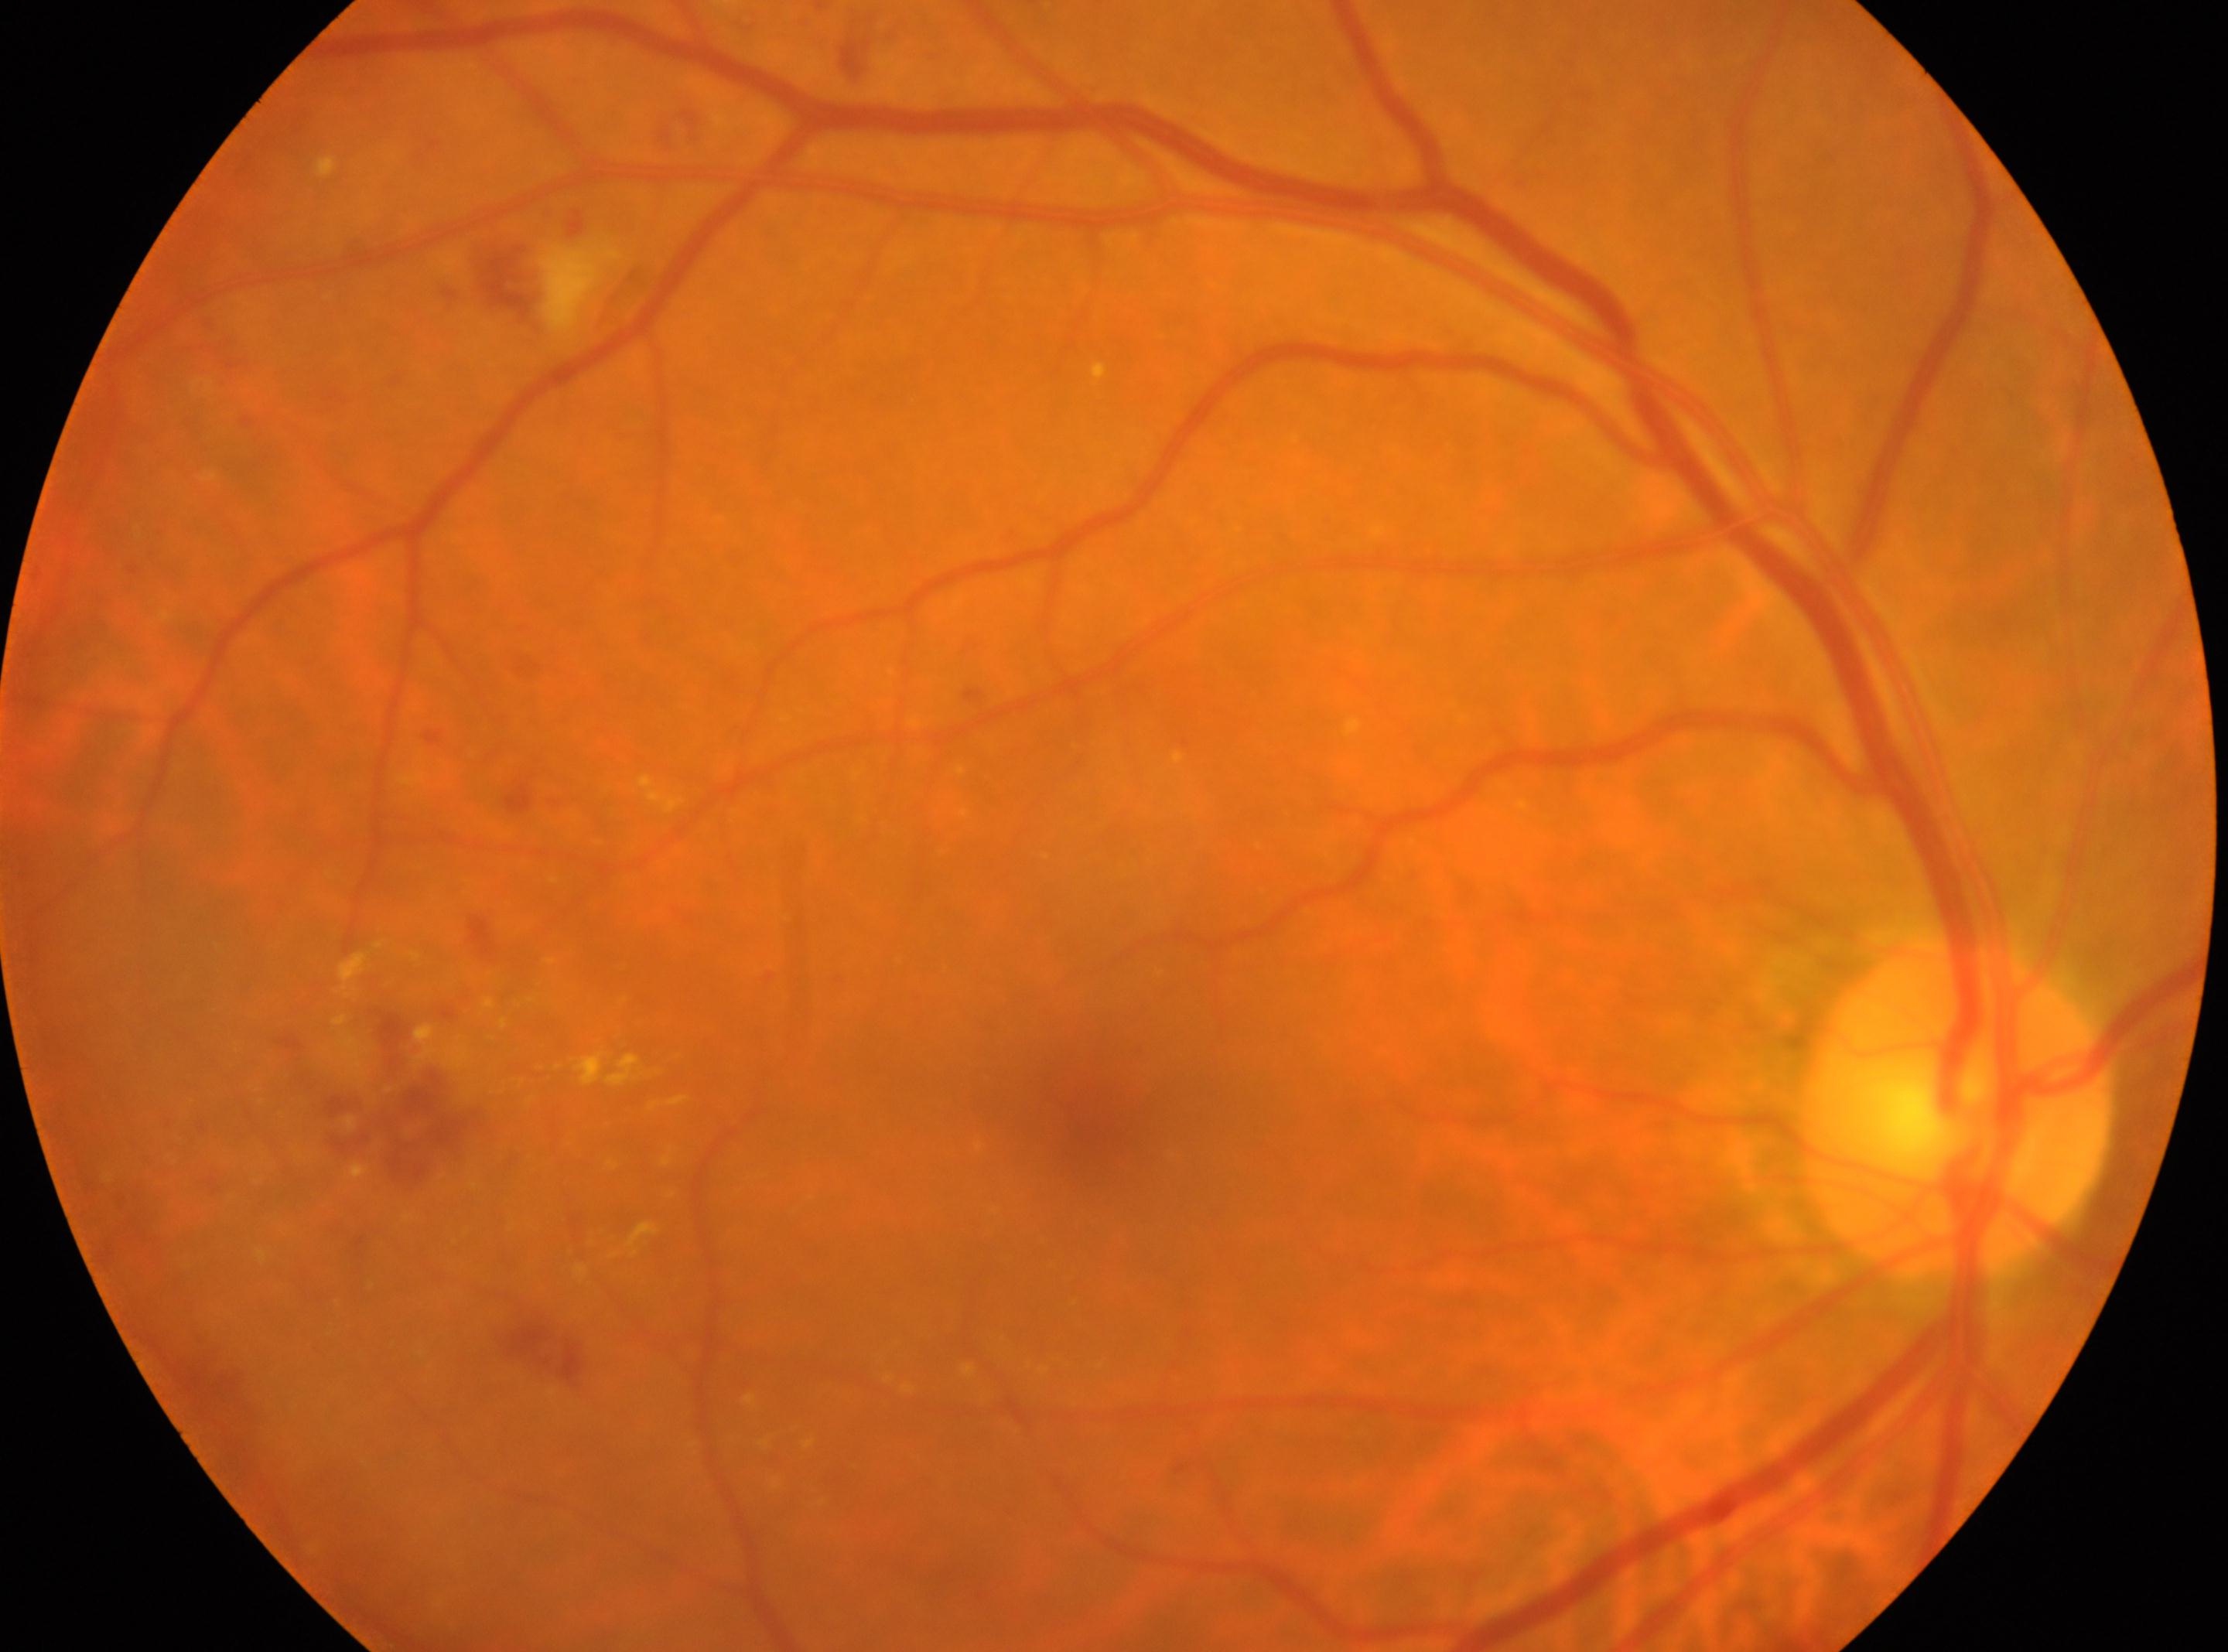 the optic disc@1953px, 1108px; DR stage@2; fovea center@1095px, 1135px; the right eye.